Acquired on the Clarity RetCam 3 · wide-field fundus photograph of an infant.
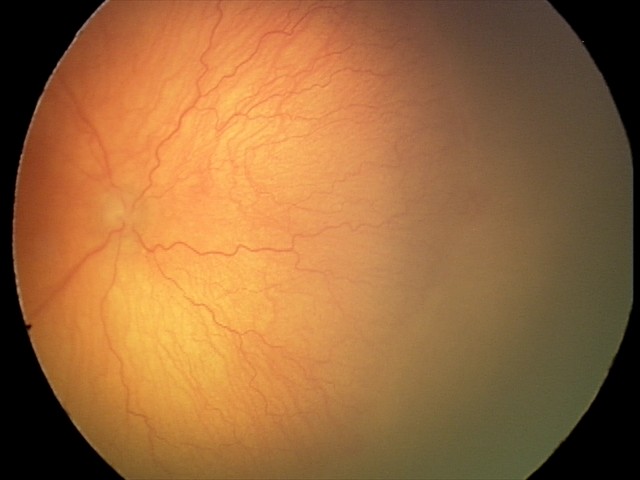
Assessment: aggressive retinopathy of prematurity